1470x1137, CFP: 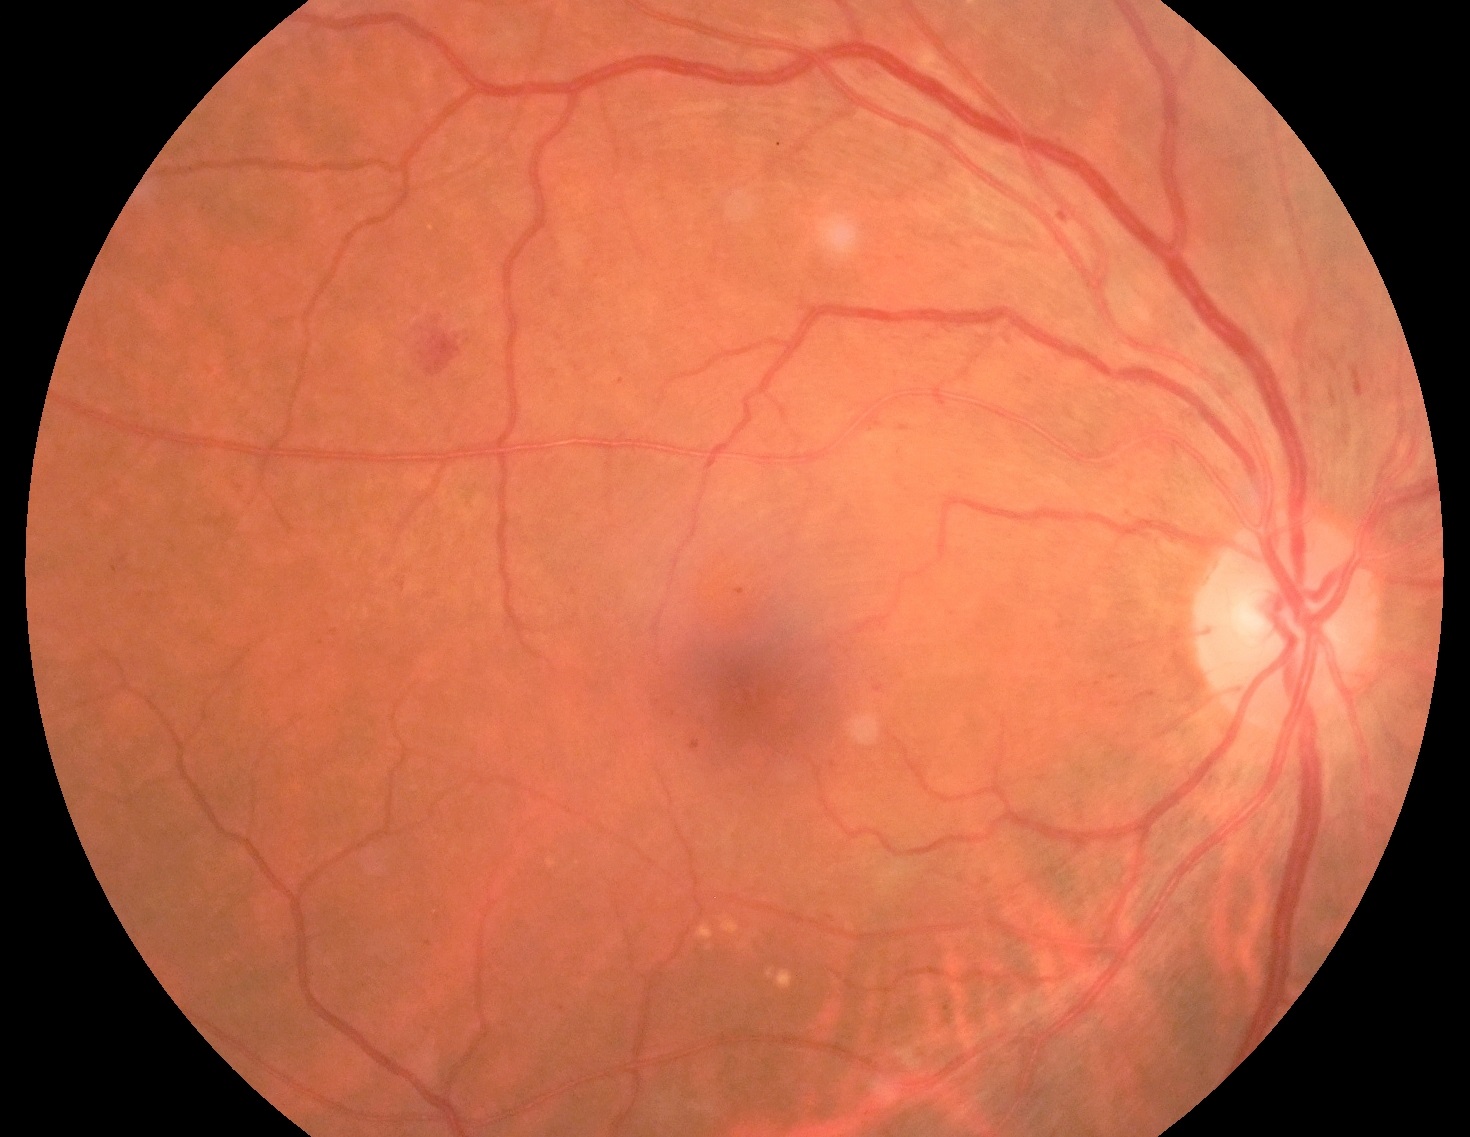
diabetic retinopathy severity: grade 2 (moderate NPDR).